Acquired with a NIDEK AFC-230. 848x848. Posterior pole photograph. 45° FOV — 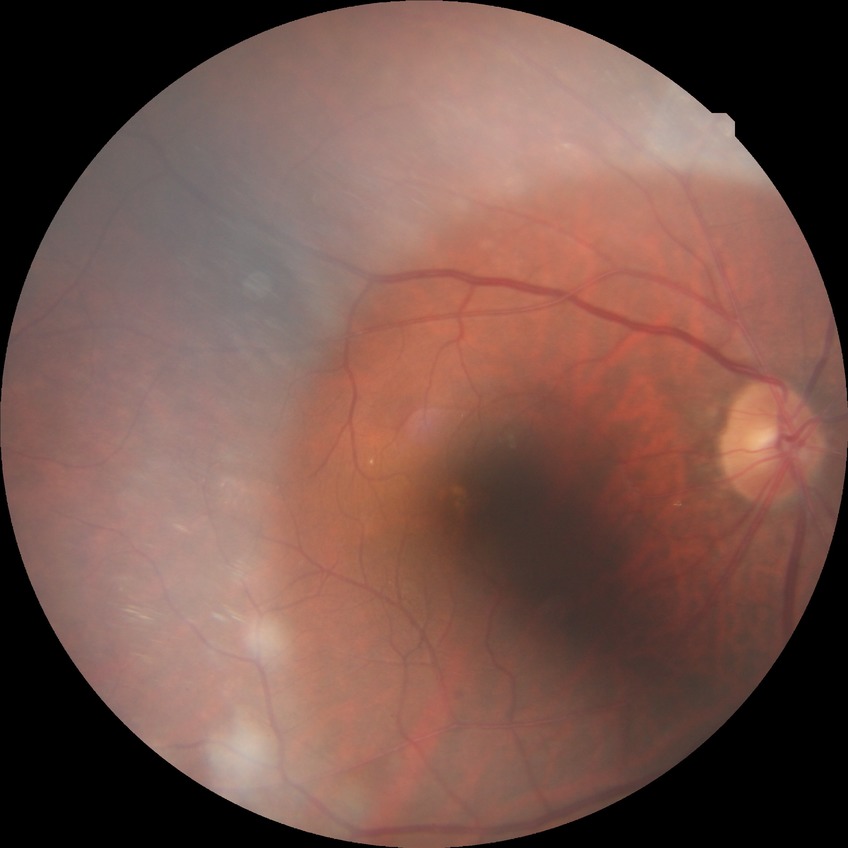 Findings:
- modified Davis grading: no diabetic retinopathy